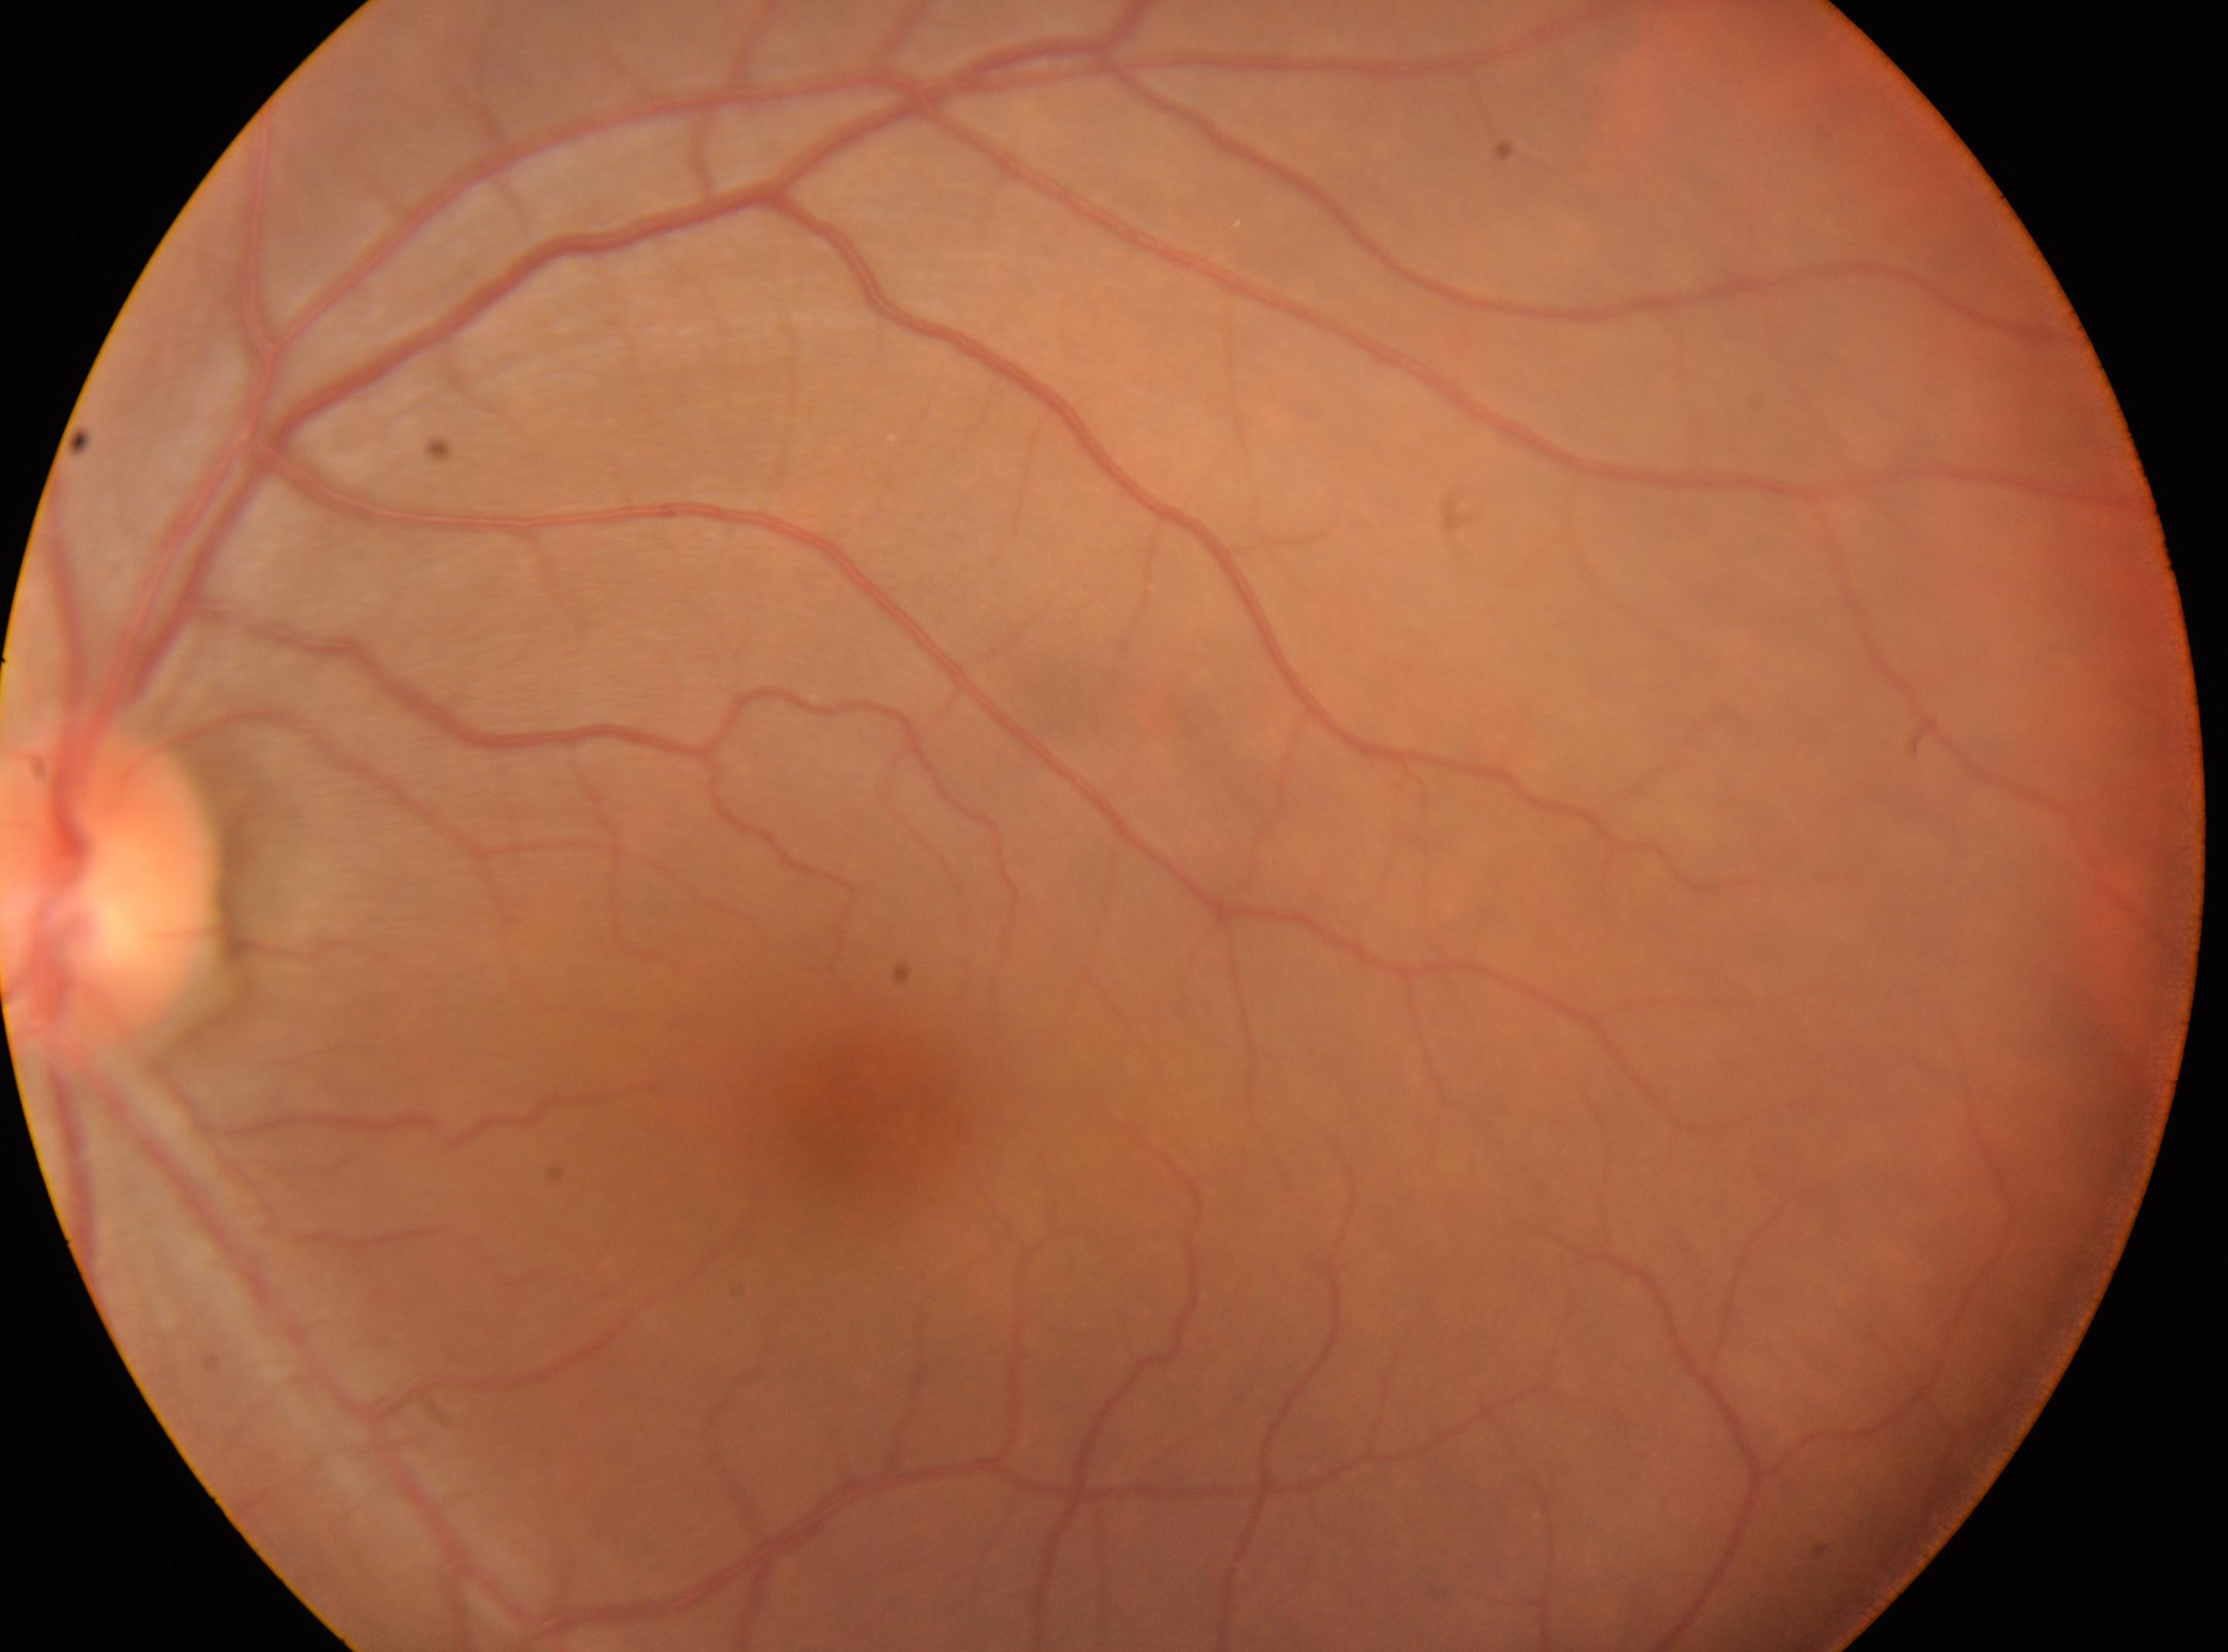

The macular center is at (859,1112). The optic disc center is at (112,885). DR: no apparent diabetic retinopathy (grade 0). Imaged eye: the left eye.